848x848px, NIDEK AFC-230 fundus camera: 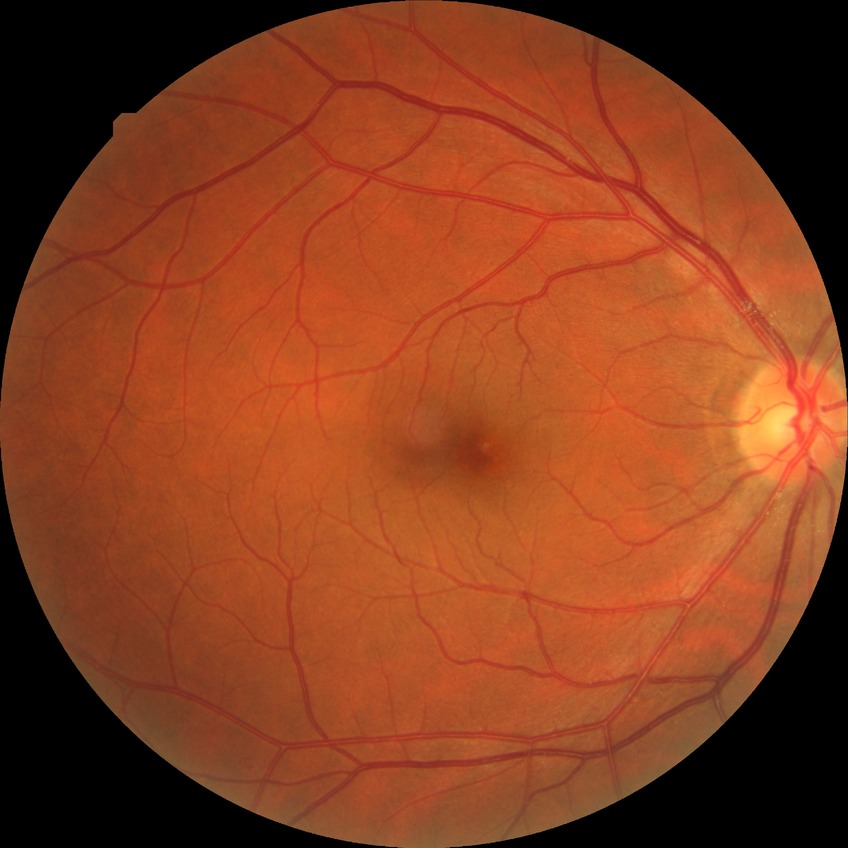
Findings:
- diabetic retinopathy severity — no diabetic retinopathy